Fundus photo taken with a portable handheld camera
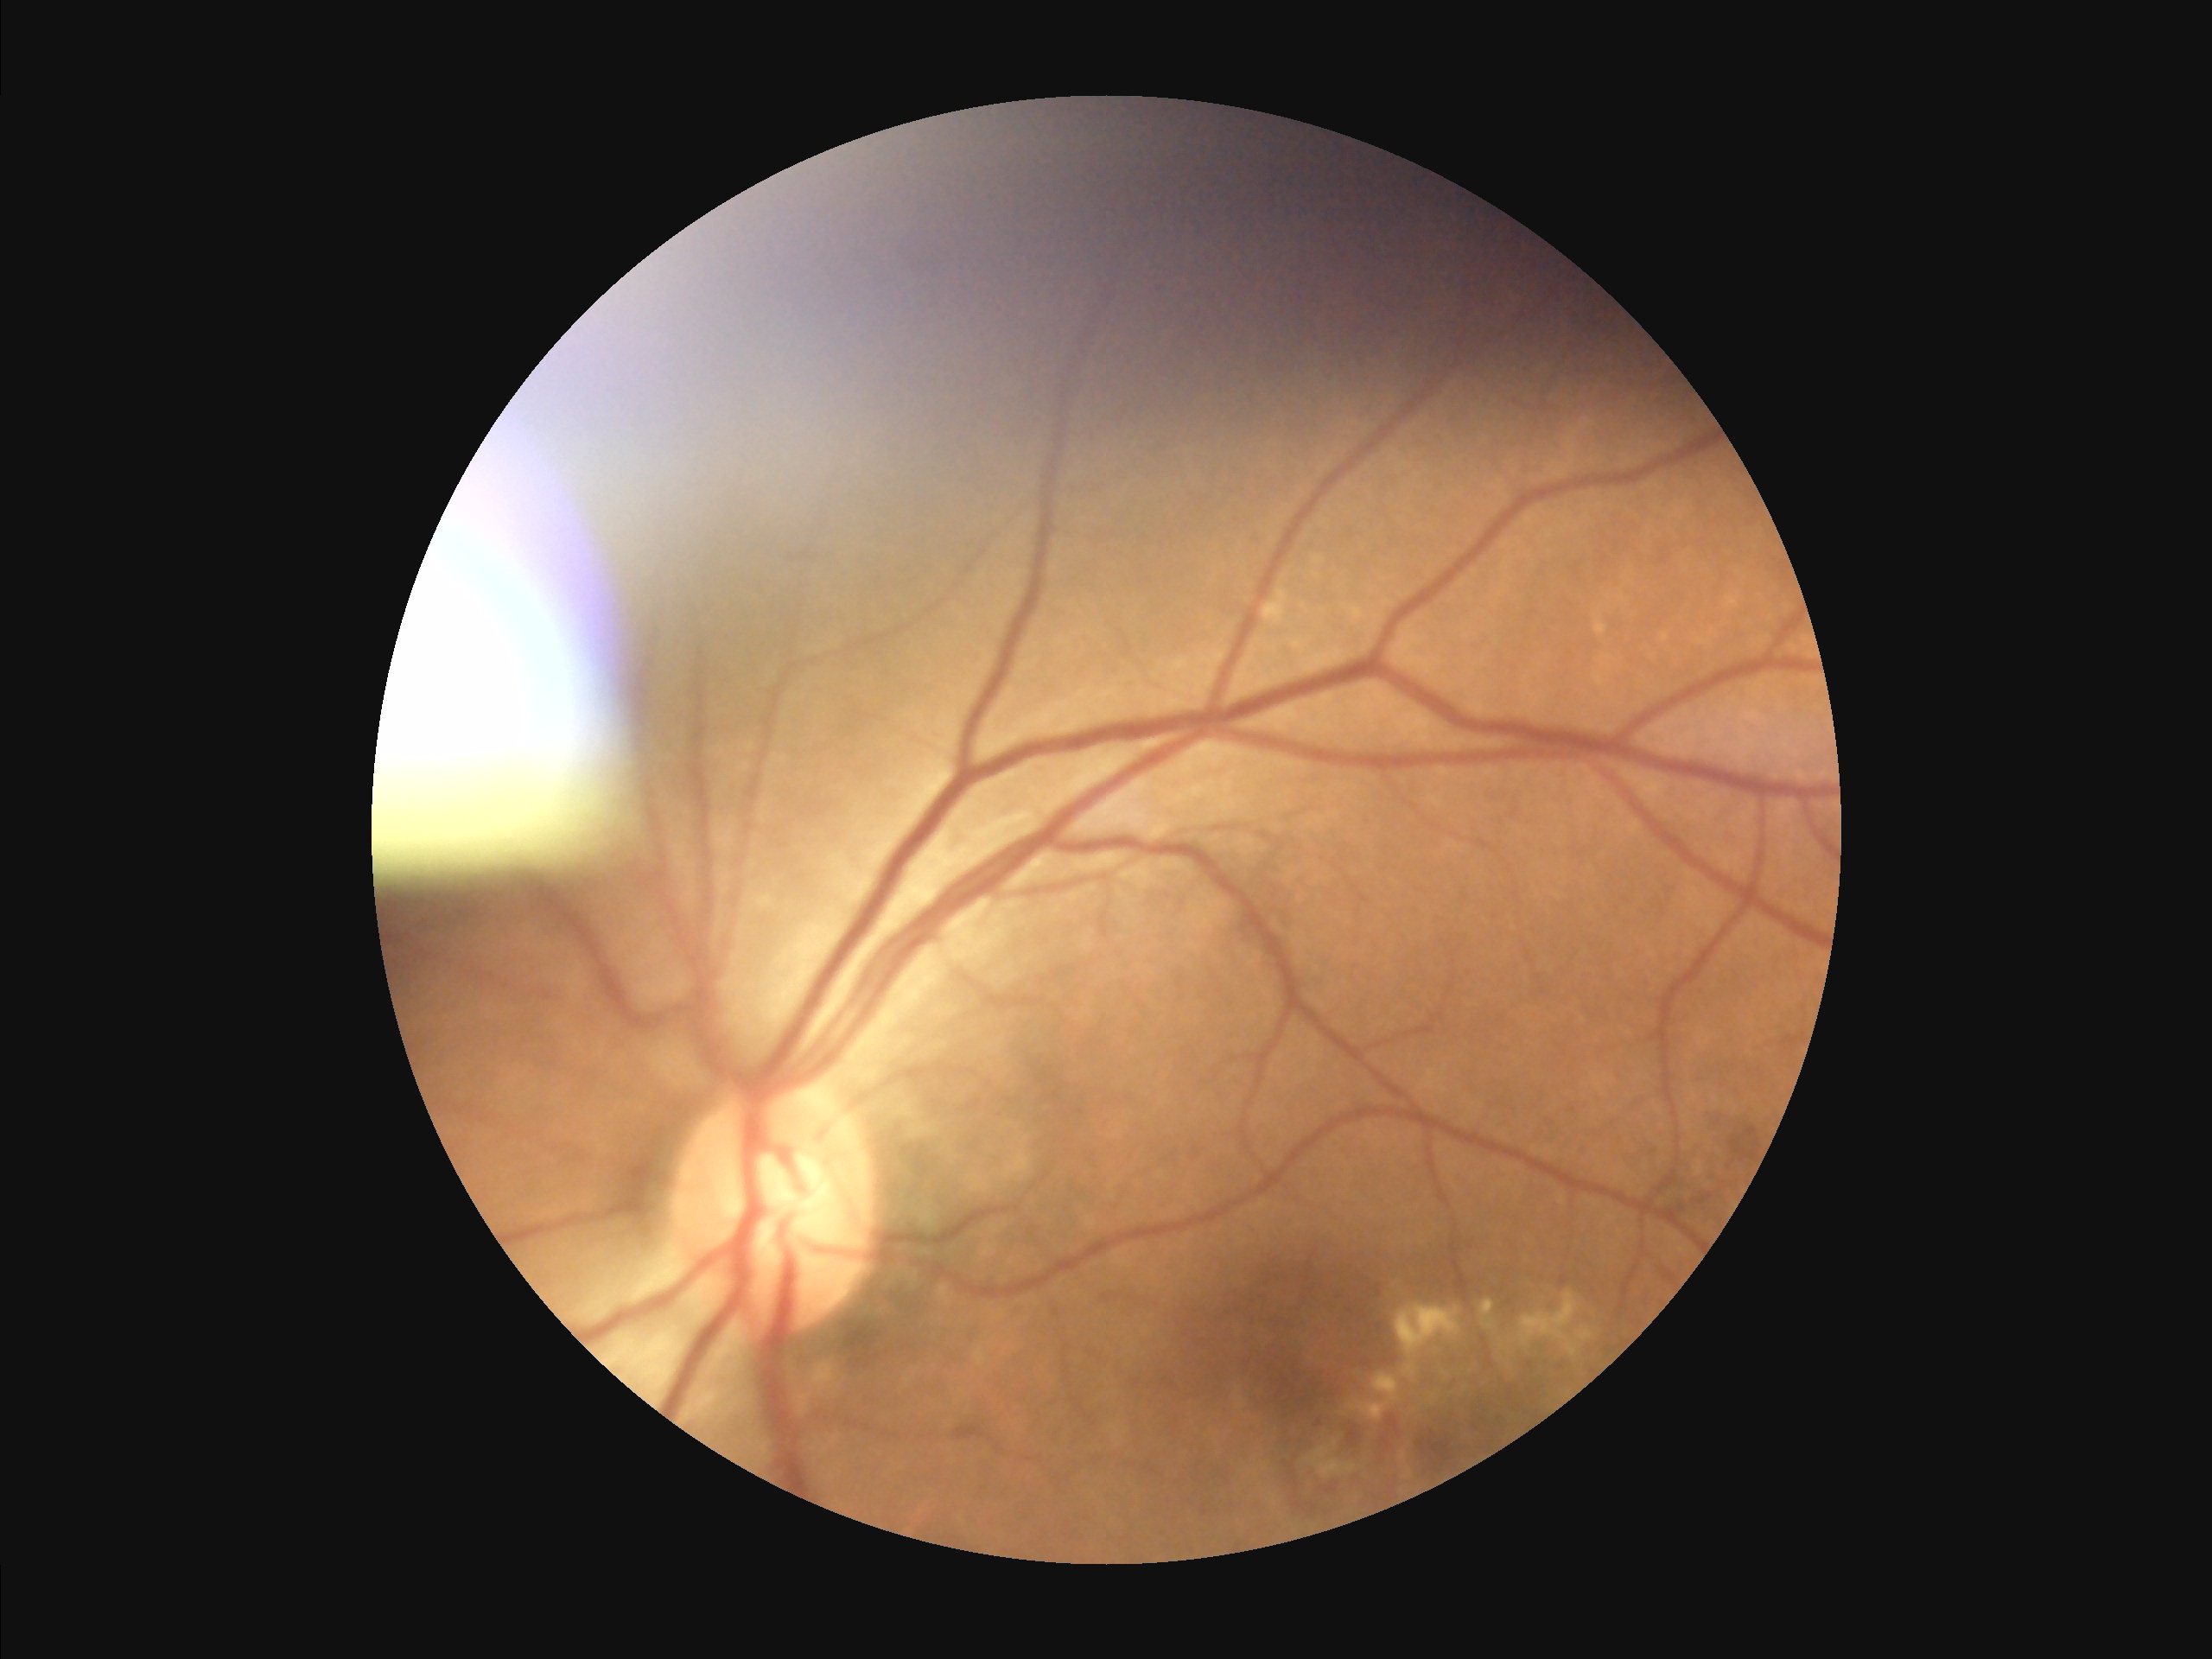

{
  "illumination": "suboptimal",
  "clarity": "reduced",
  "overall_quality": "poor",
  "contrast": "adequate"
}